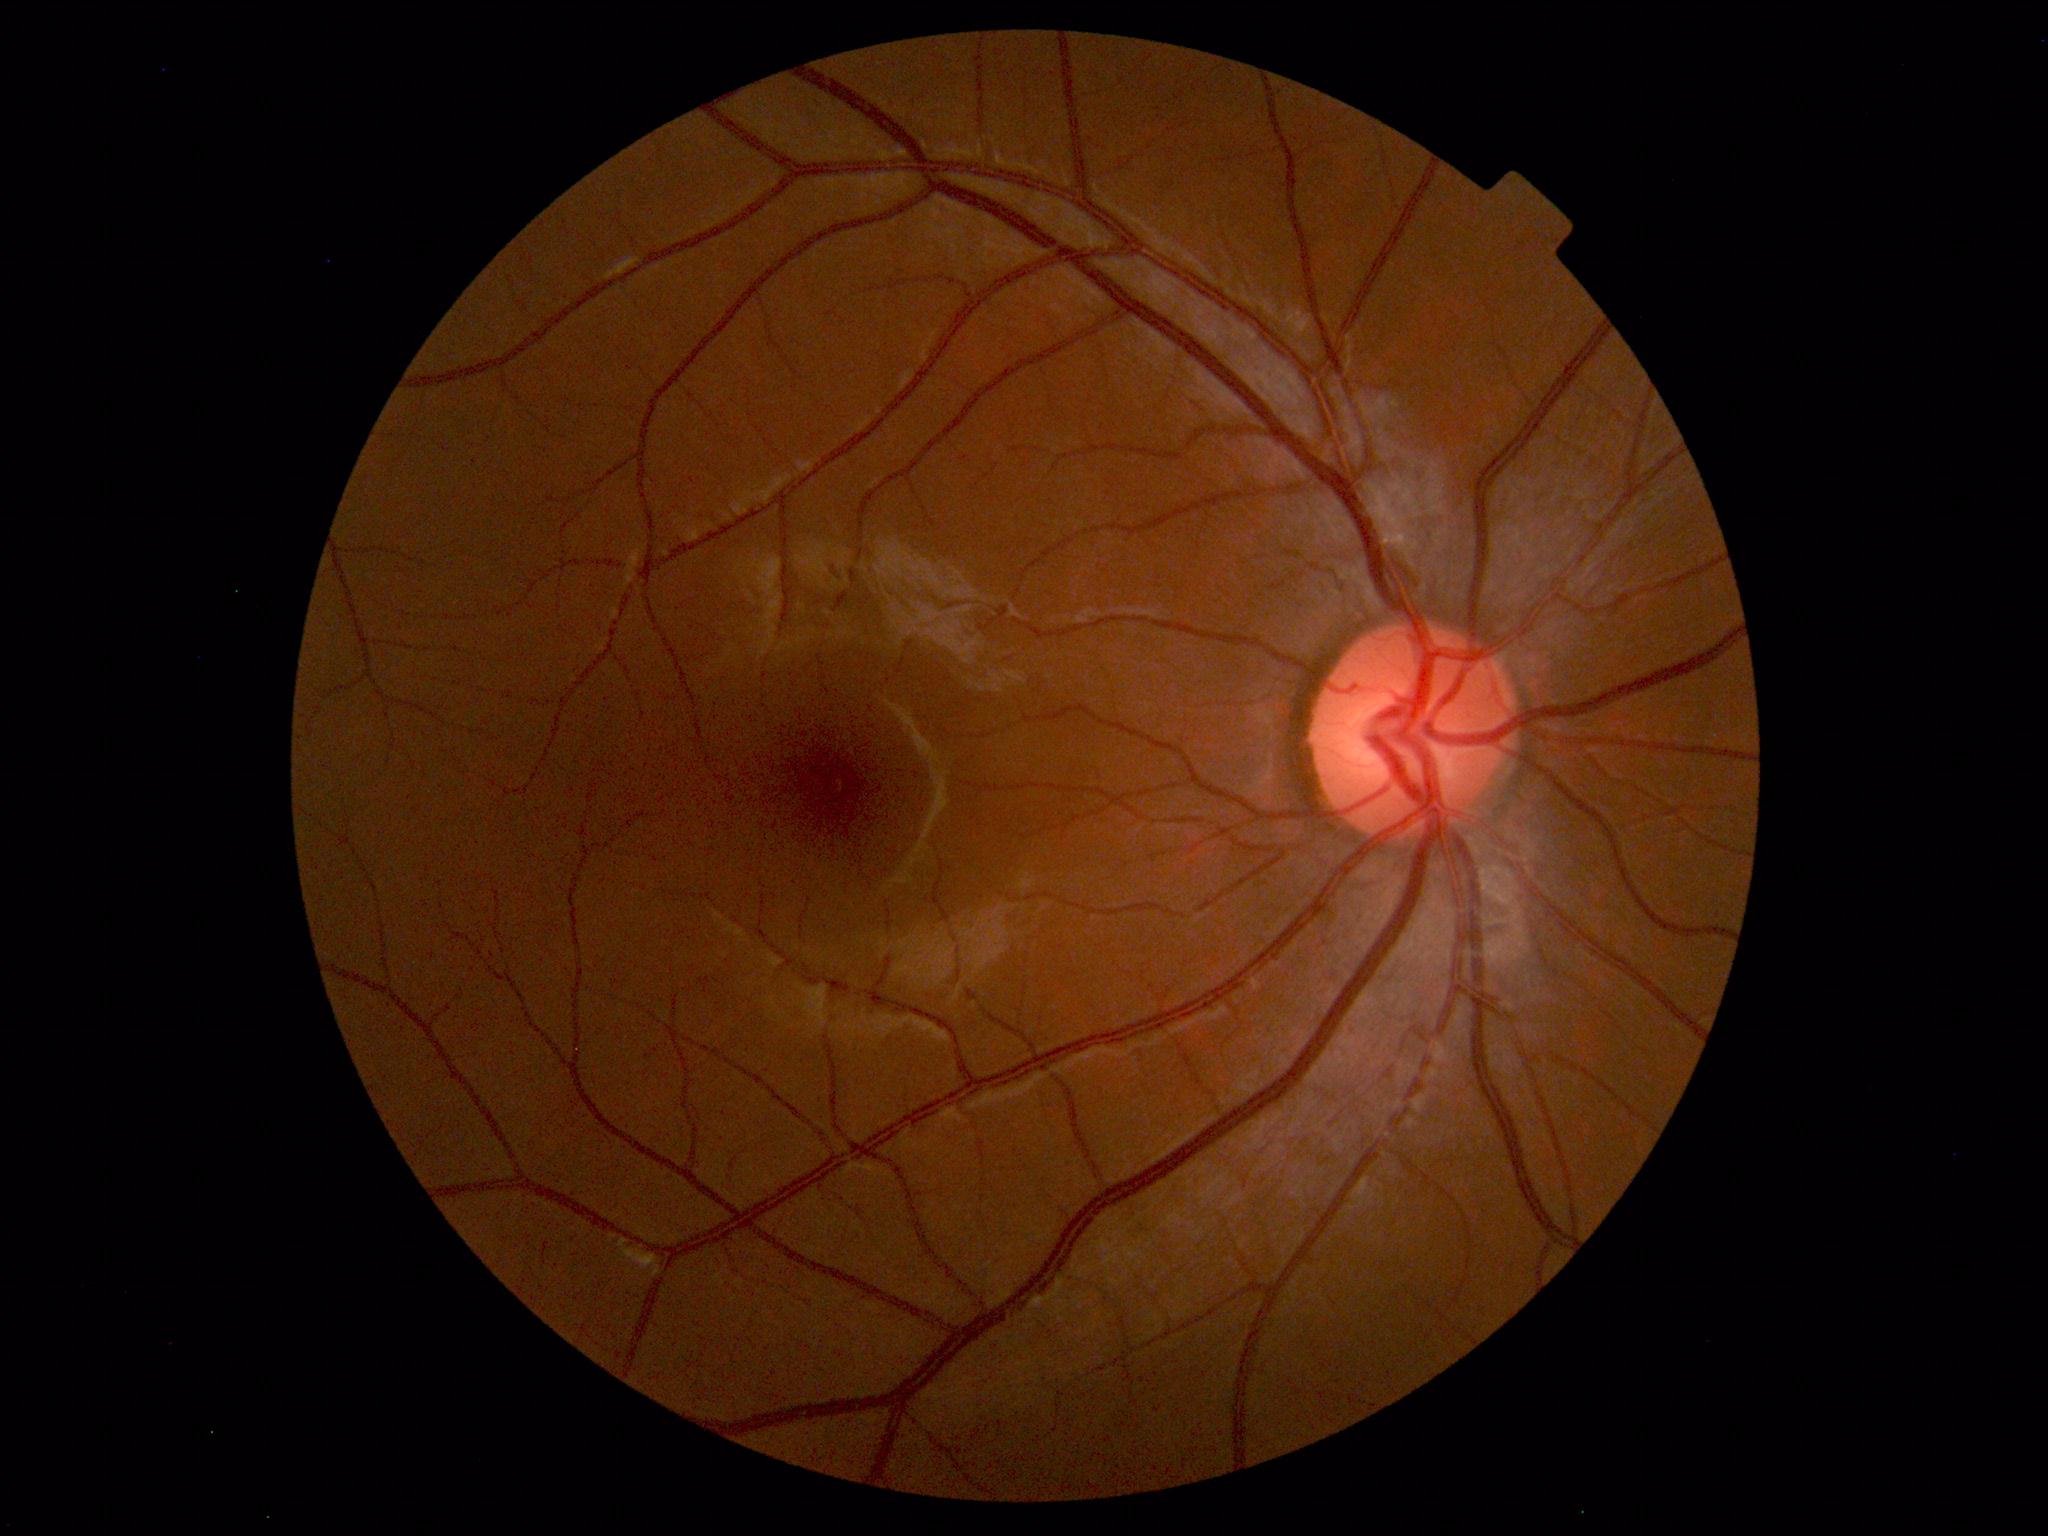
Fundus photograph within normal limits.